Fundus photo; 45-degree field of view; 2212 by 1672 pixels: 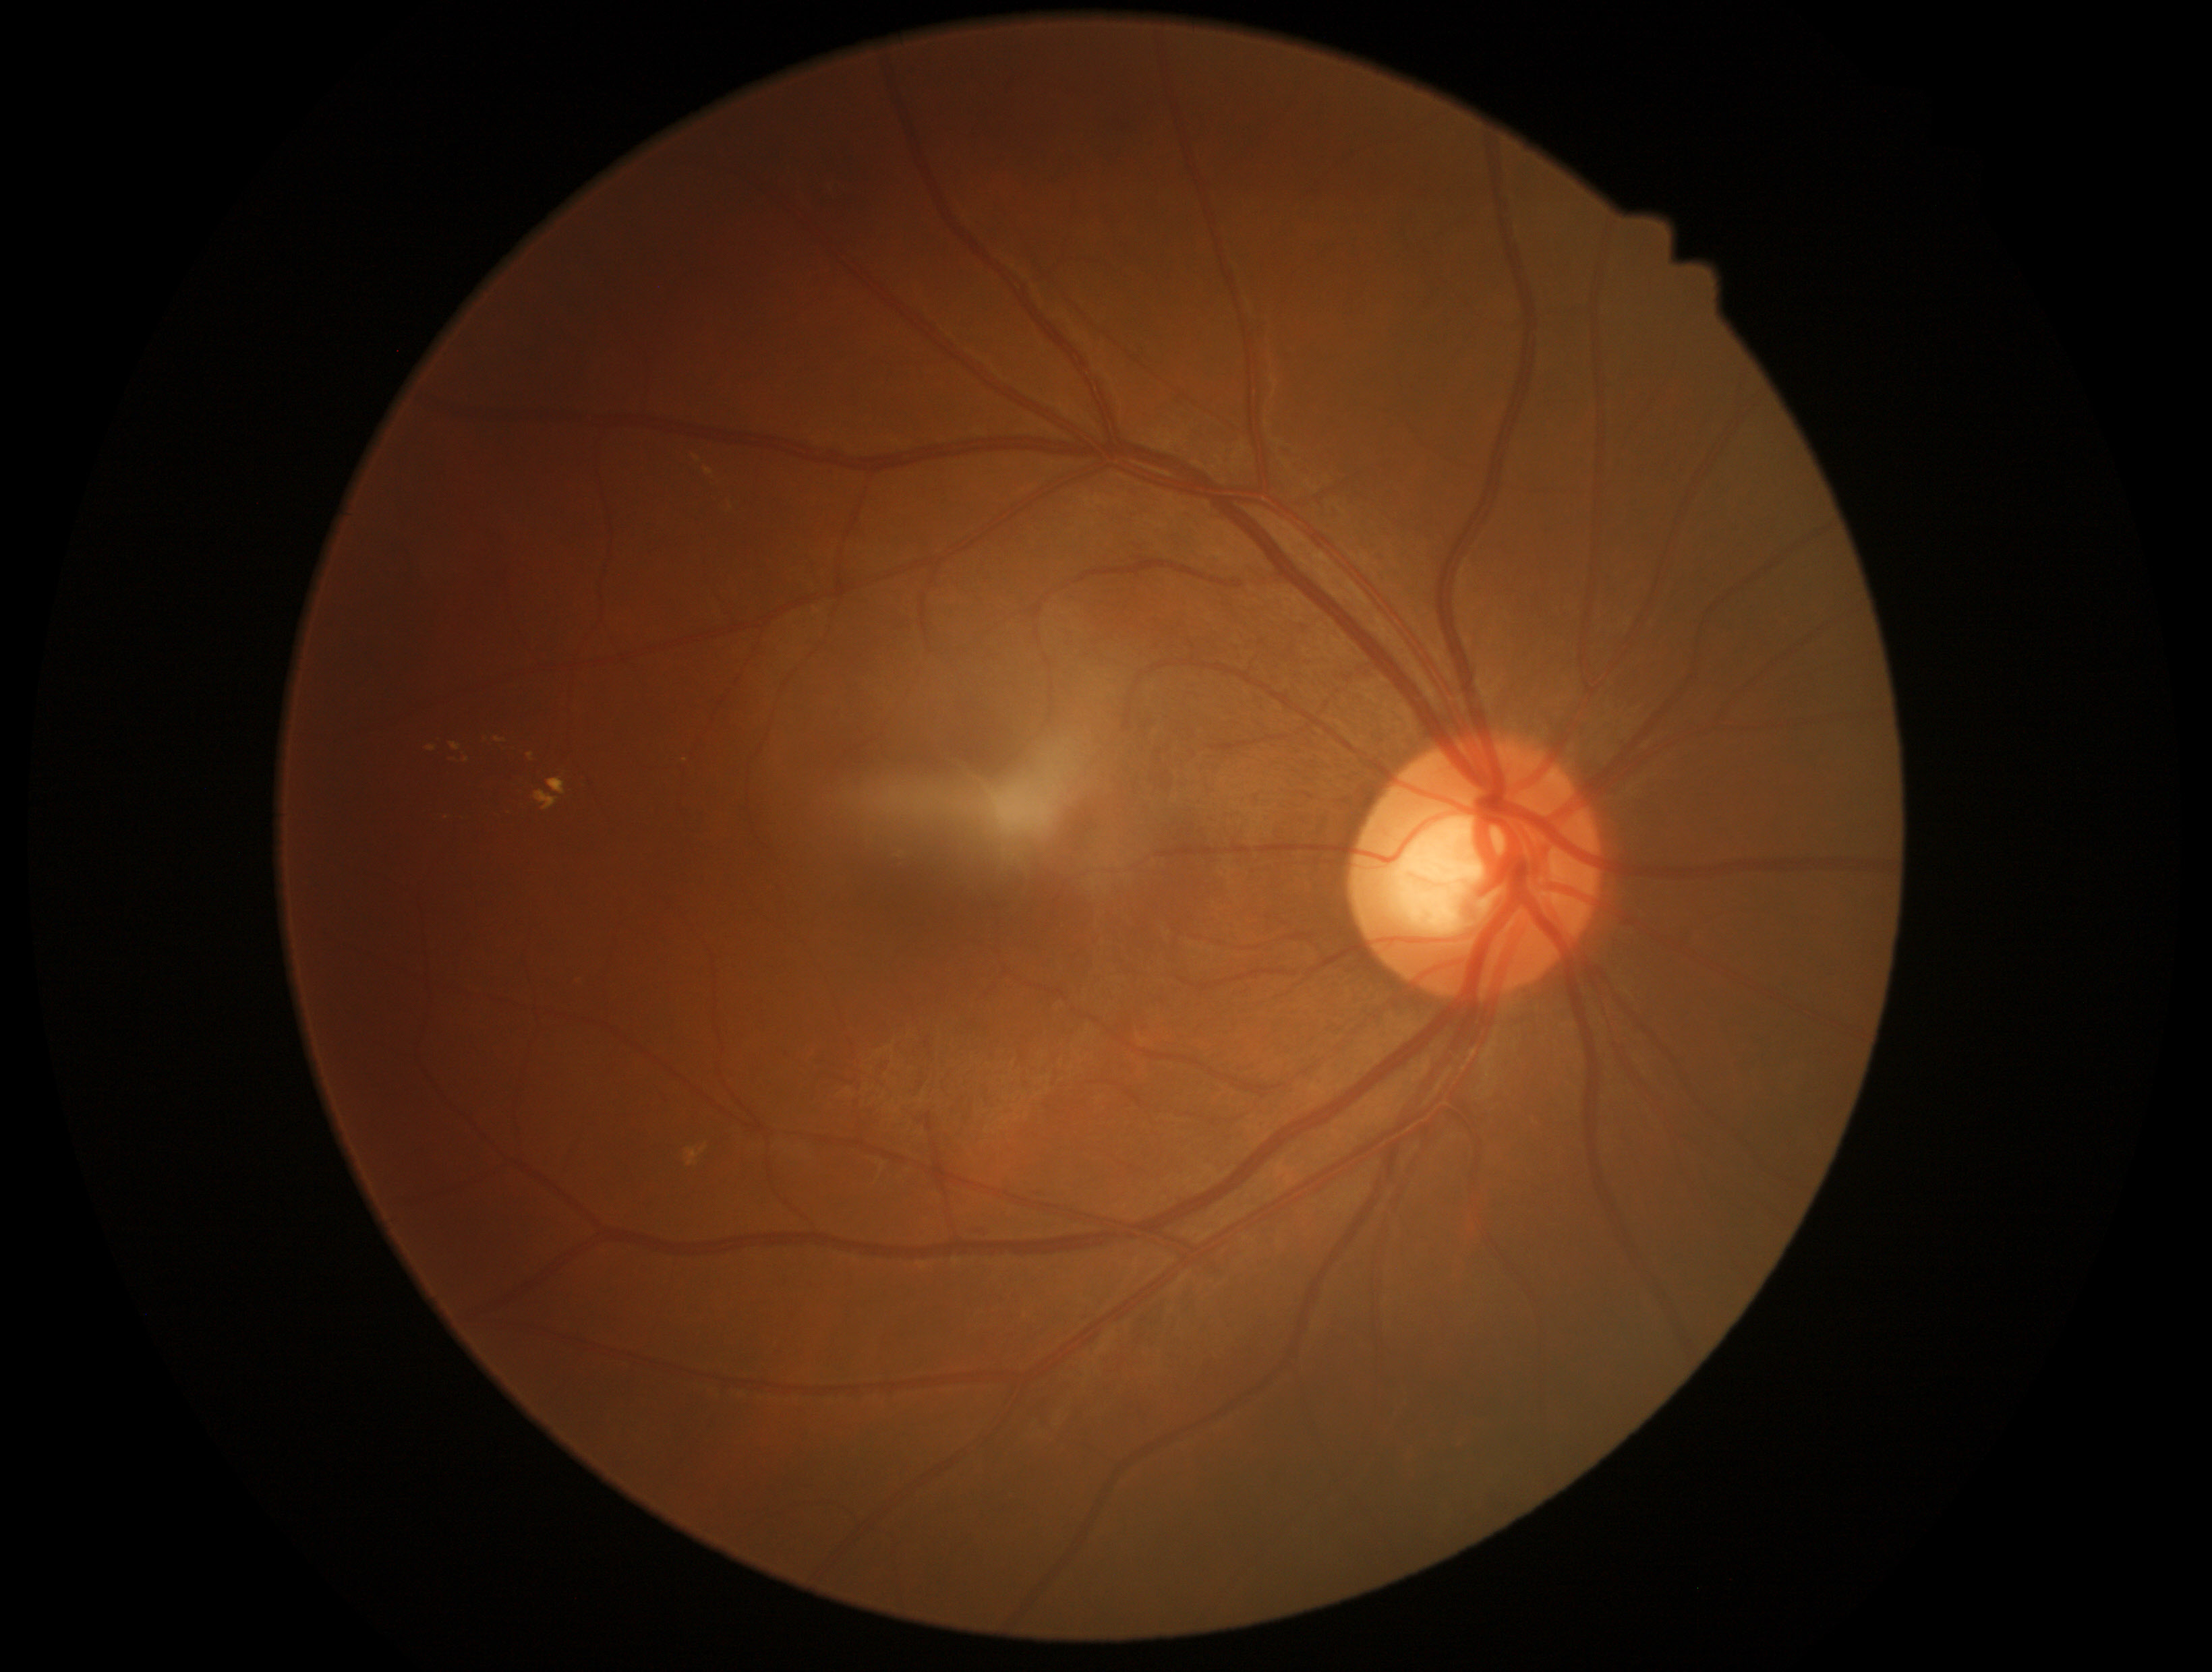

Diabetic retinopathy grade is 2 (moderate NPDR).